45° field of view
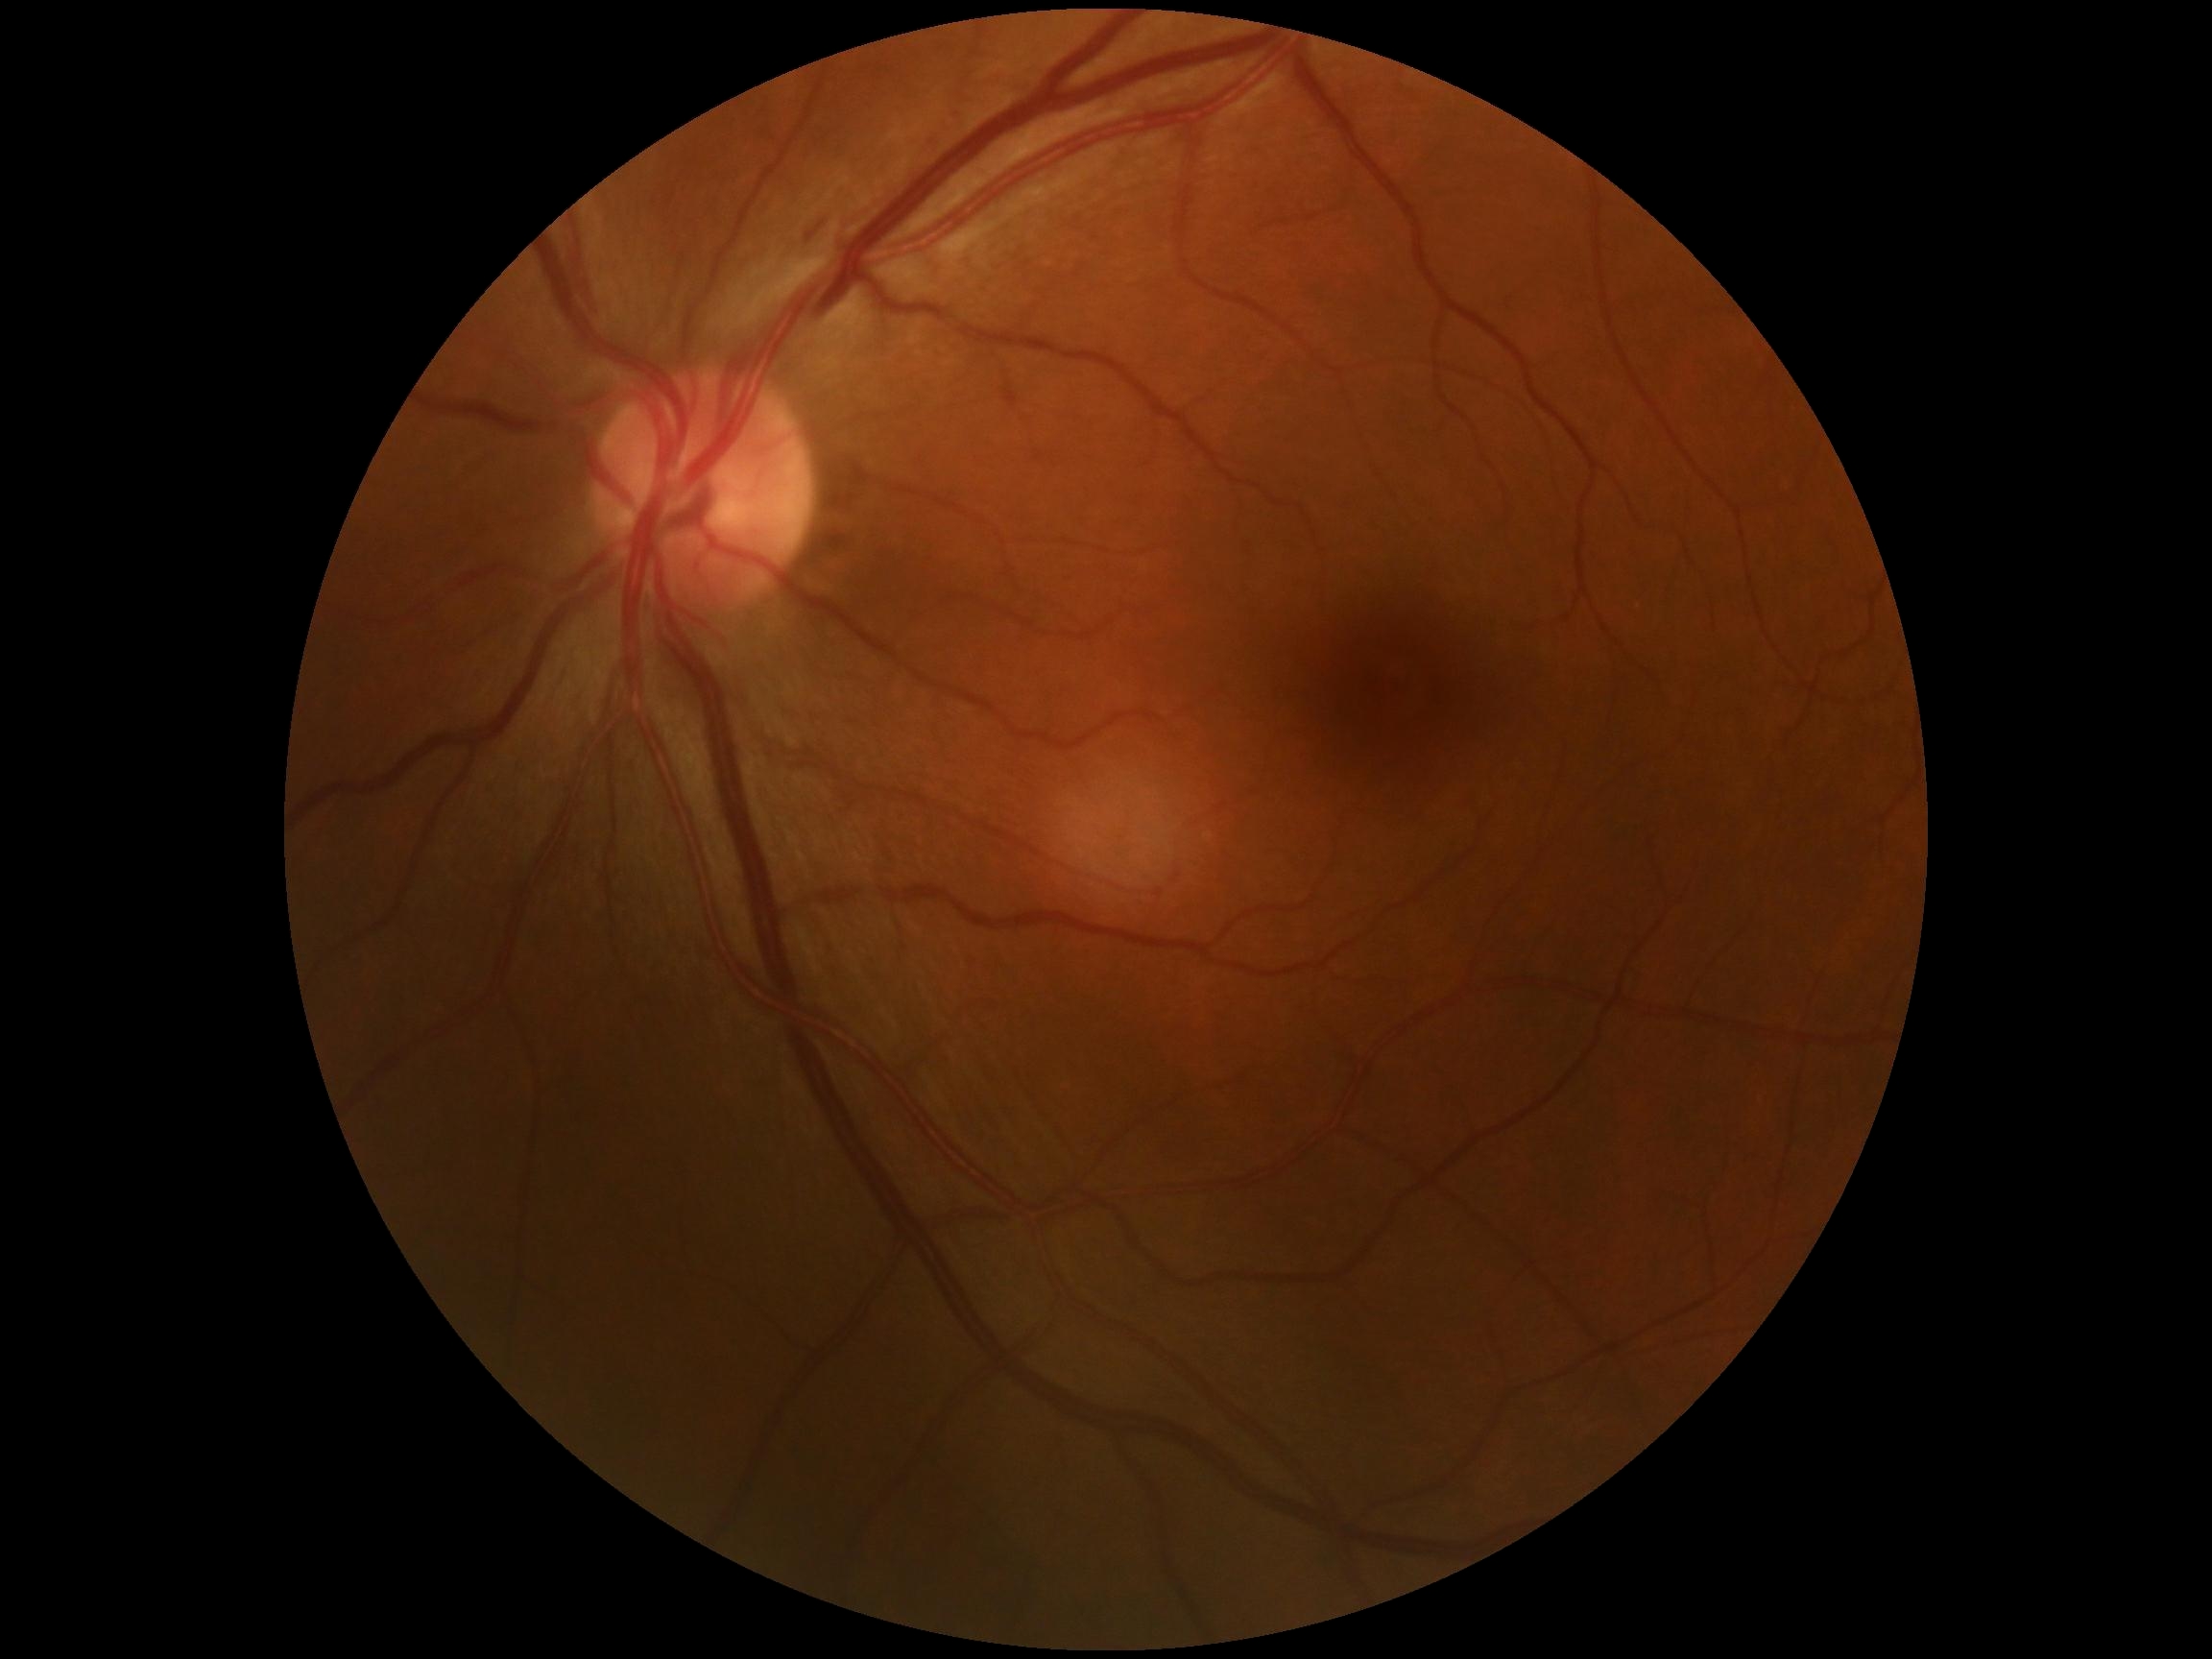
diabetic retinopathy grade = moderate non-proliferative diabetic retinopathy (2).